Retinal fundus photograph, no pharmacologic dilation, 45 degree fundus photograph, diabetic retinopathy graded by the modified Davis classification, camera: NIDEK AFC-230:
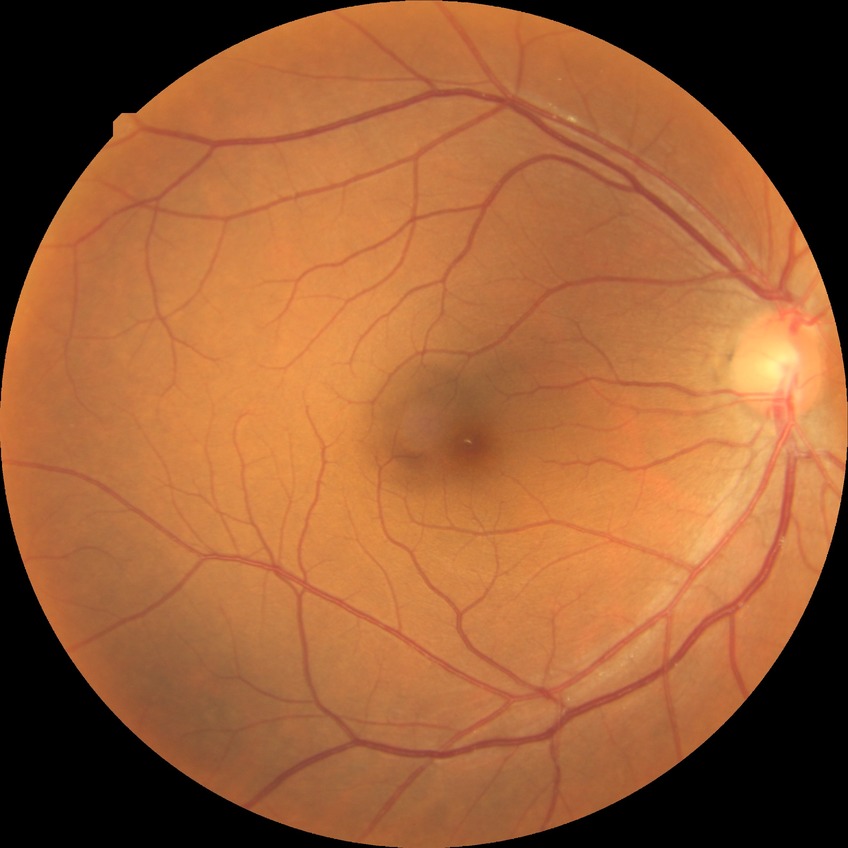
davis_grade: no diabetic retinopathy